Wide-field fundus photograph from neonatal ROP screening: 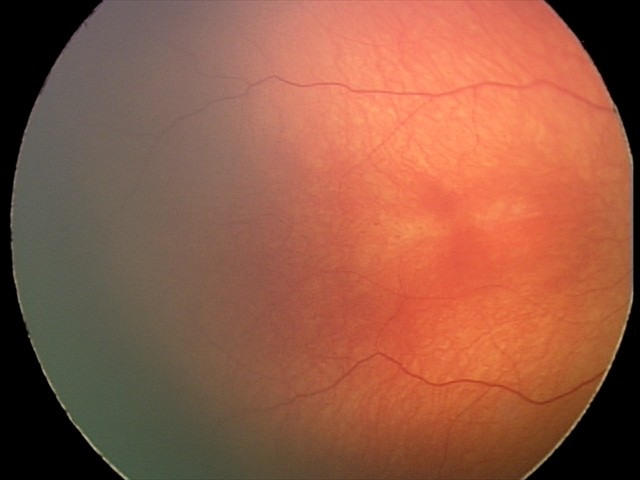
Impression: normal retinal appearance